Wide-field contact fundus photograph of an infant: 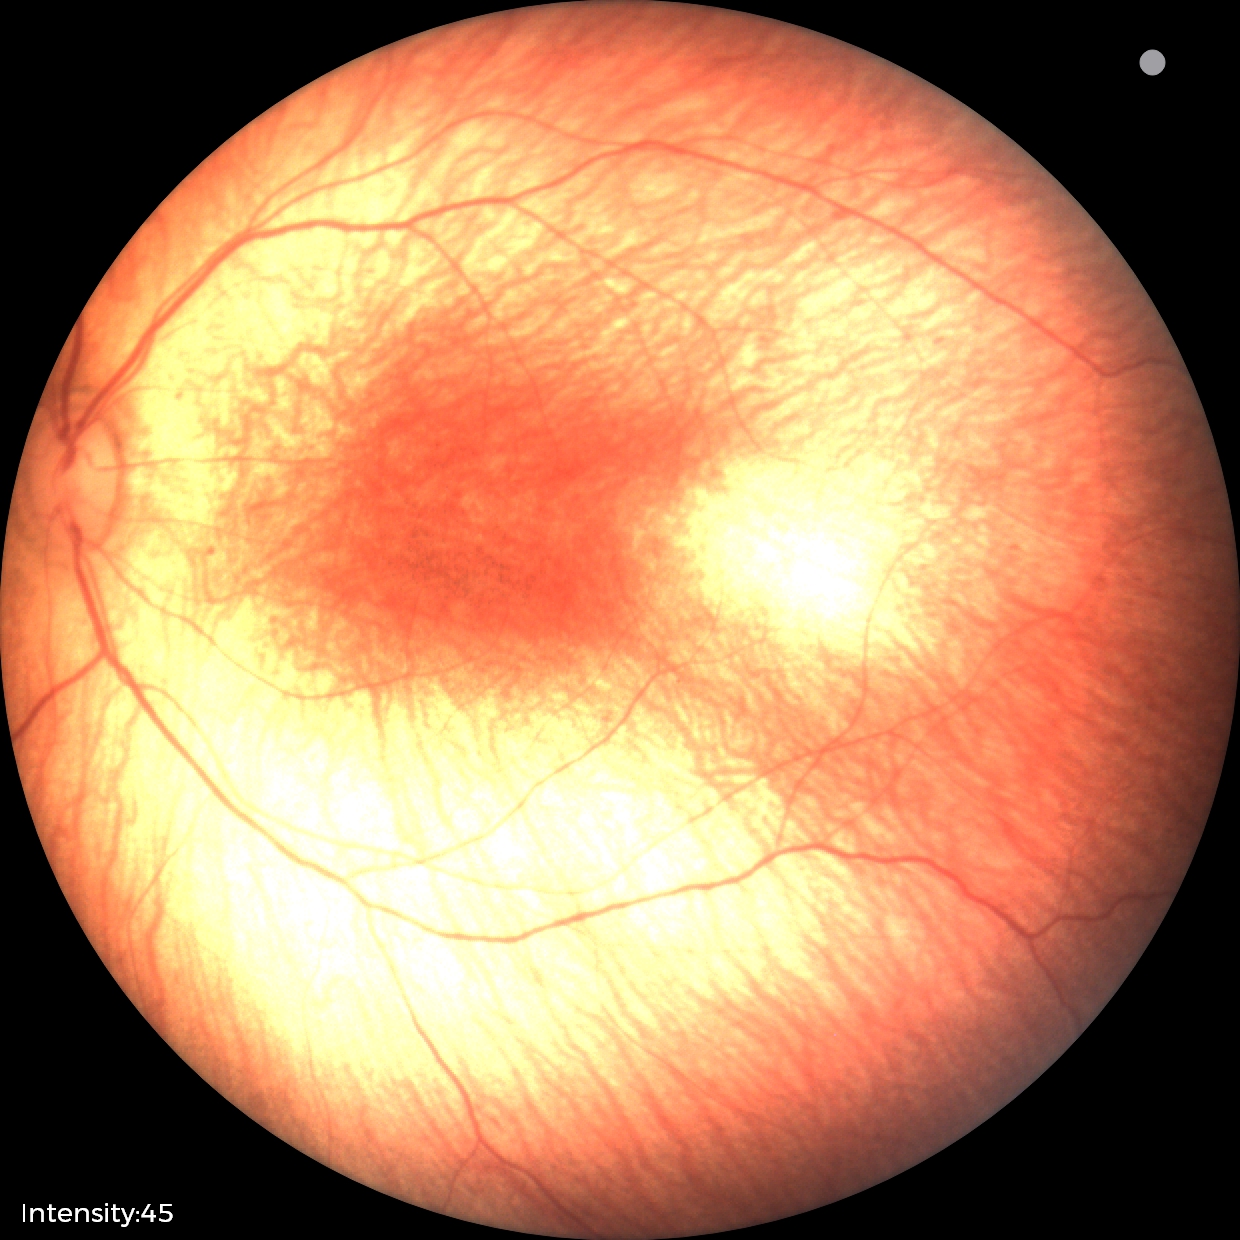 Diagnosis from this screening exam: status post ROP — retinal appearance after treated retinopathy of prematurity.